Acquired with a Kowa VX-10α:
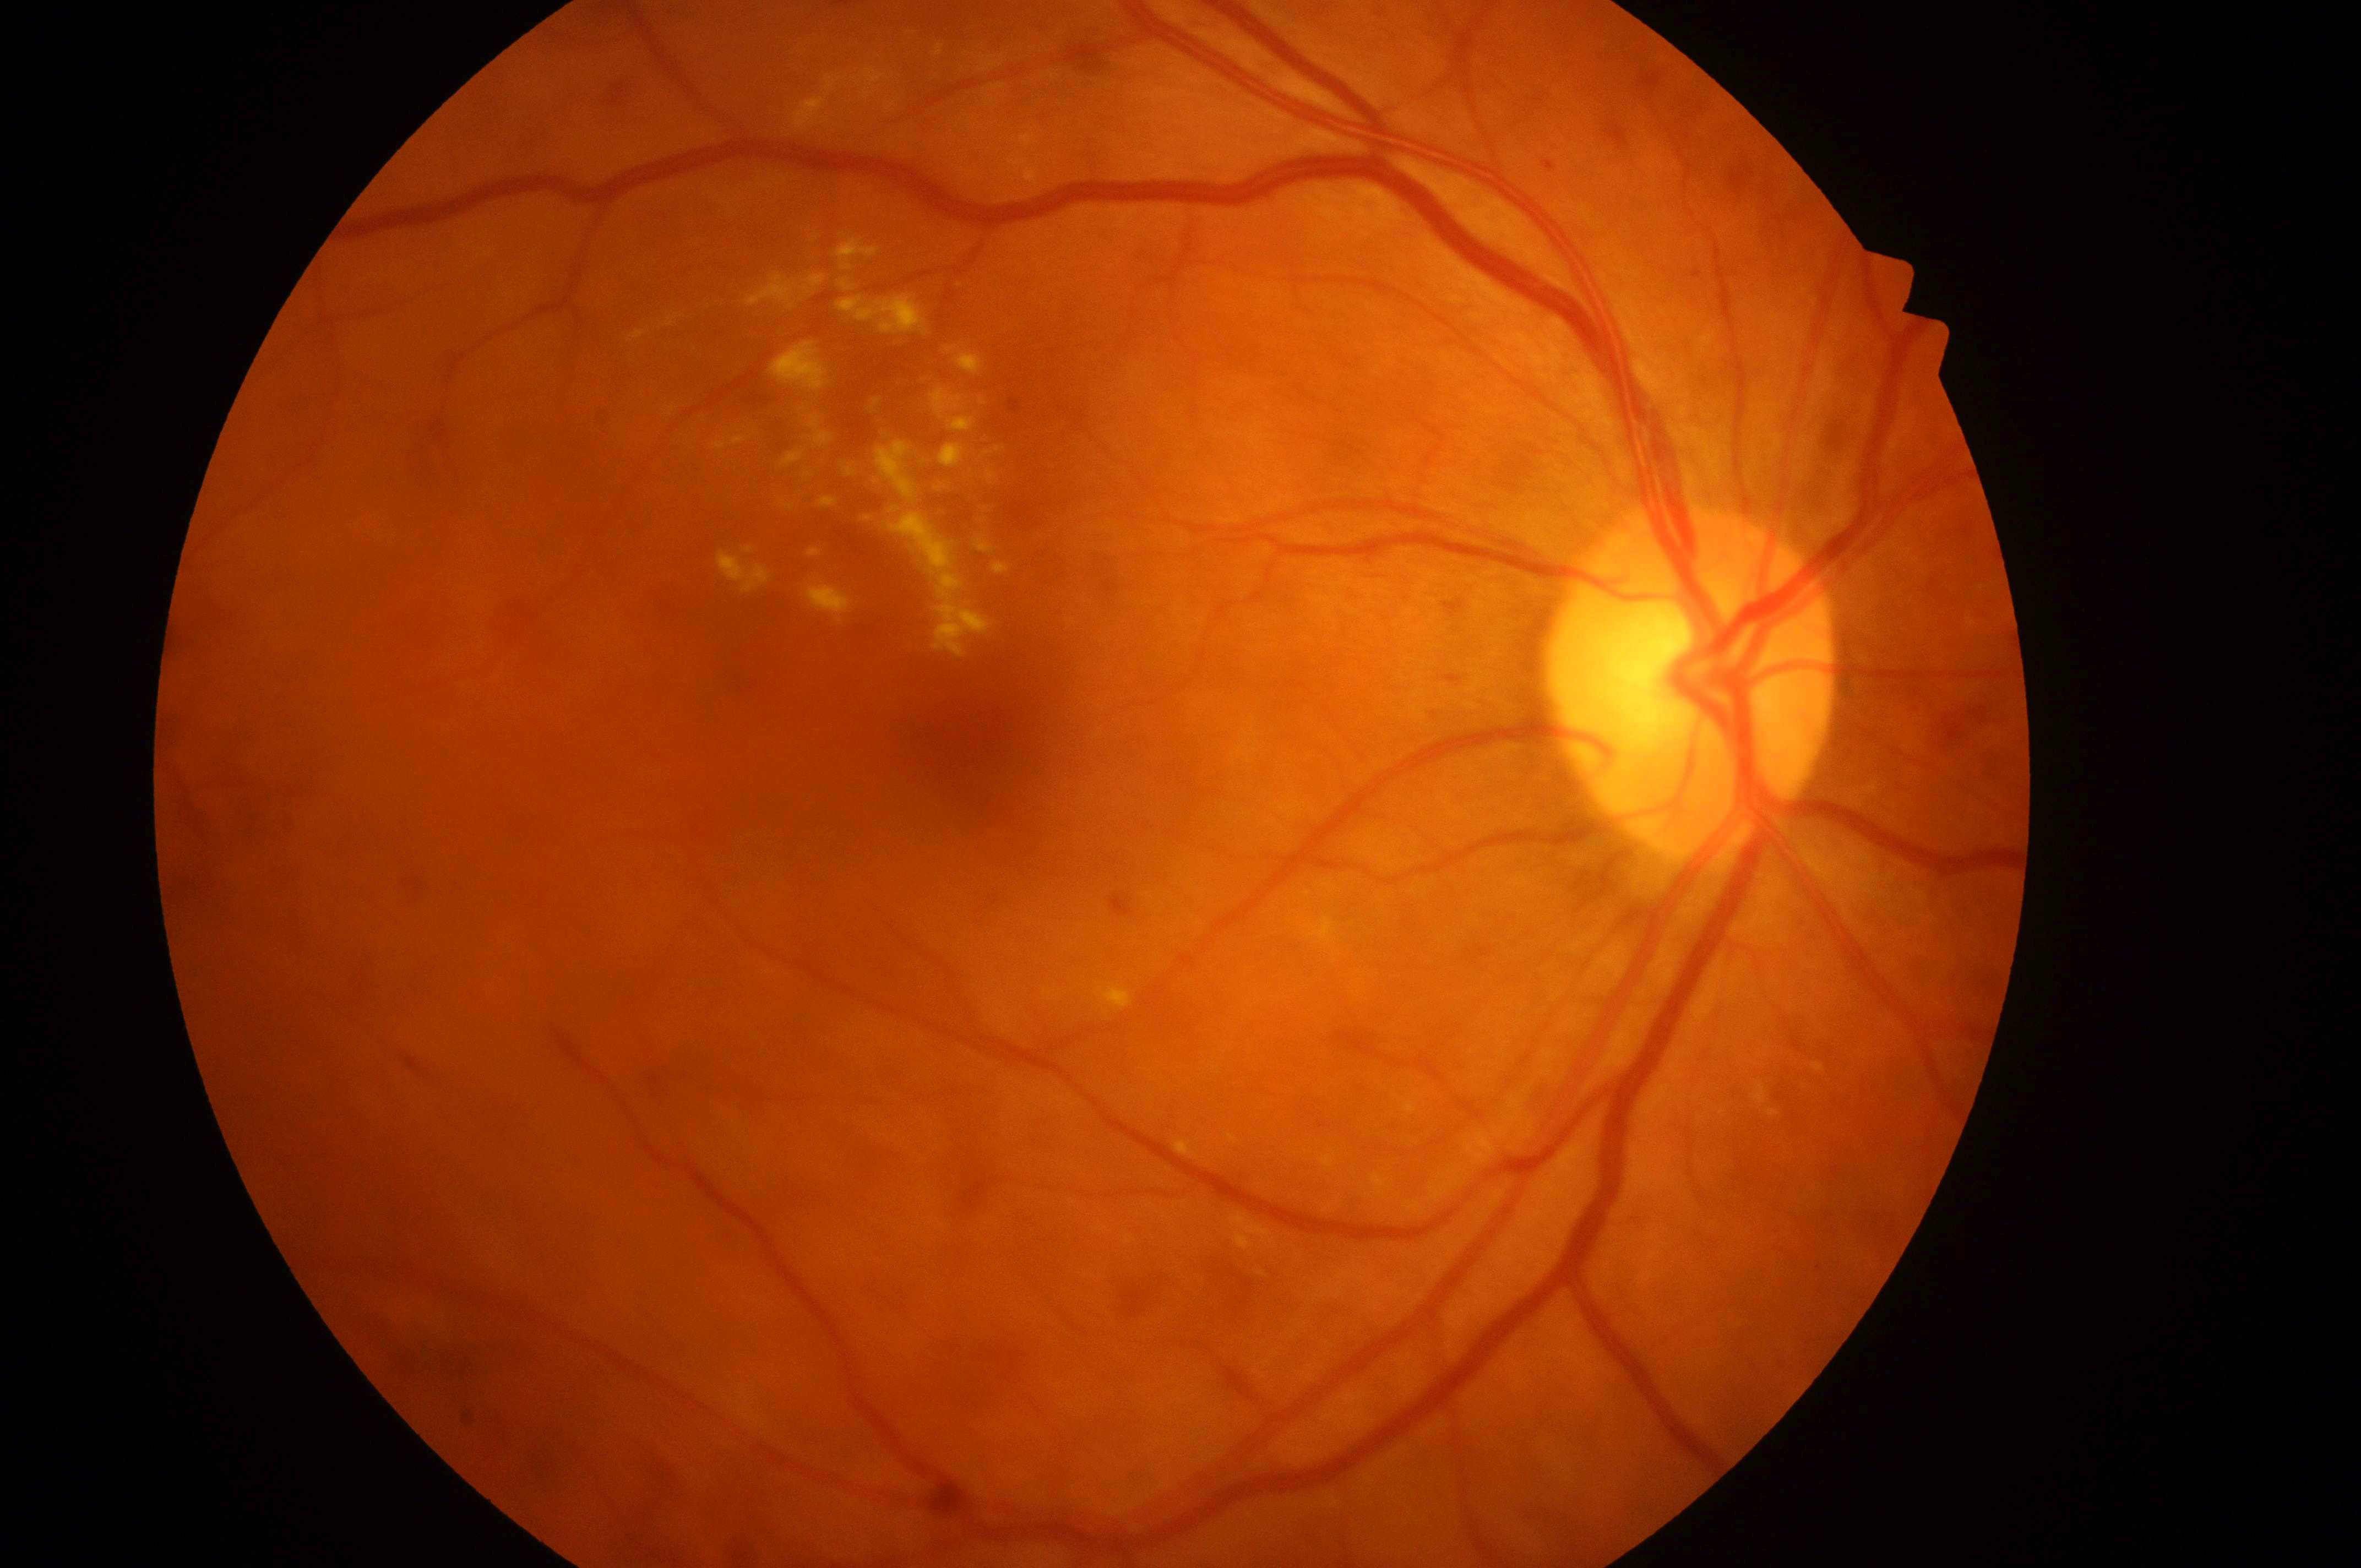
DME risk@grade 2
DR grade@2/4
the right eye
optic nerve head@1694, 687
macula center@965, 752